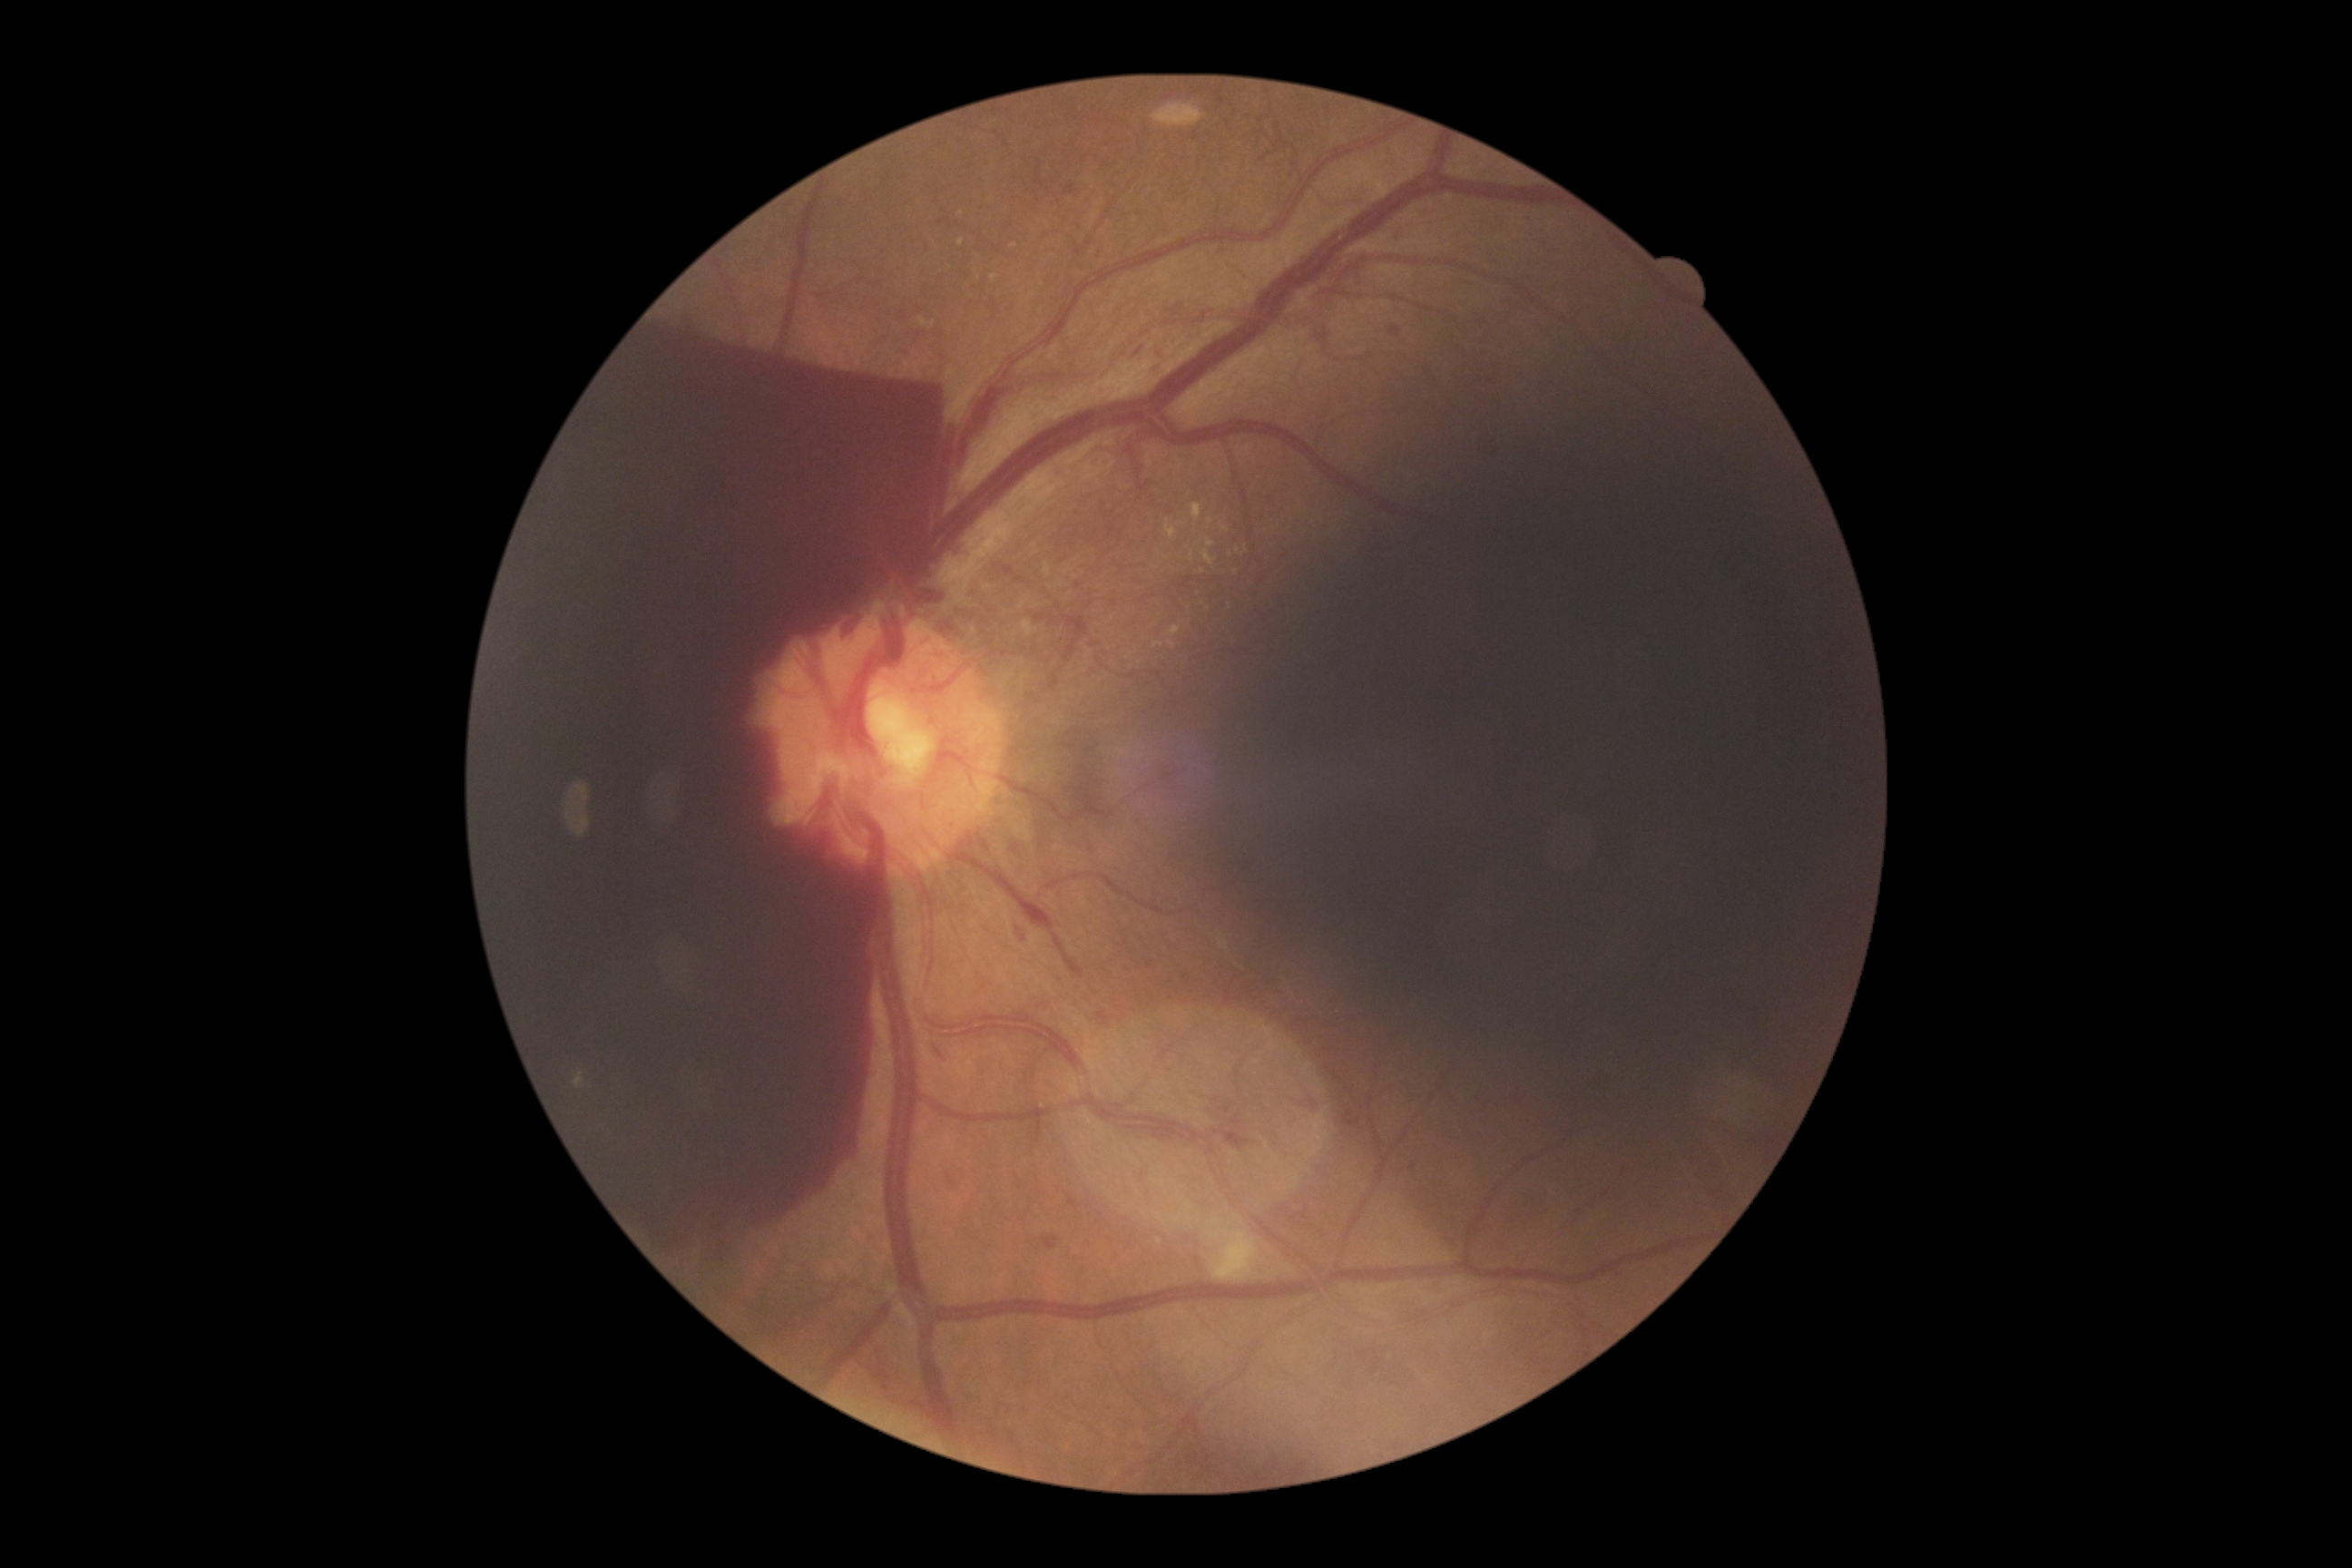

{
  "dr_category": "proliferative diabetic retinopathy",
  "dr_grade": "PDR (4) — neovascularization and/or vitreous/pre-retinal hemorrhage"
}